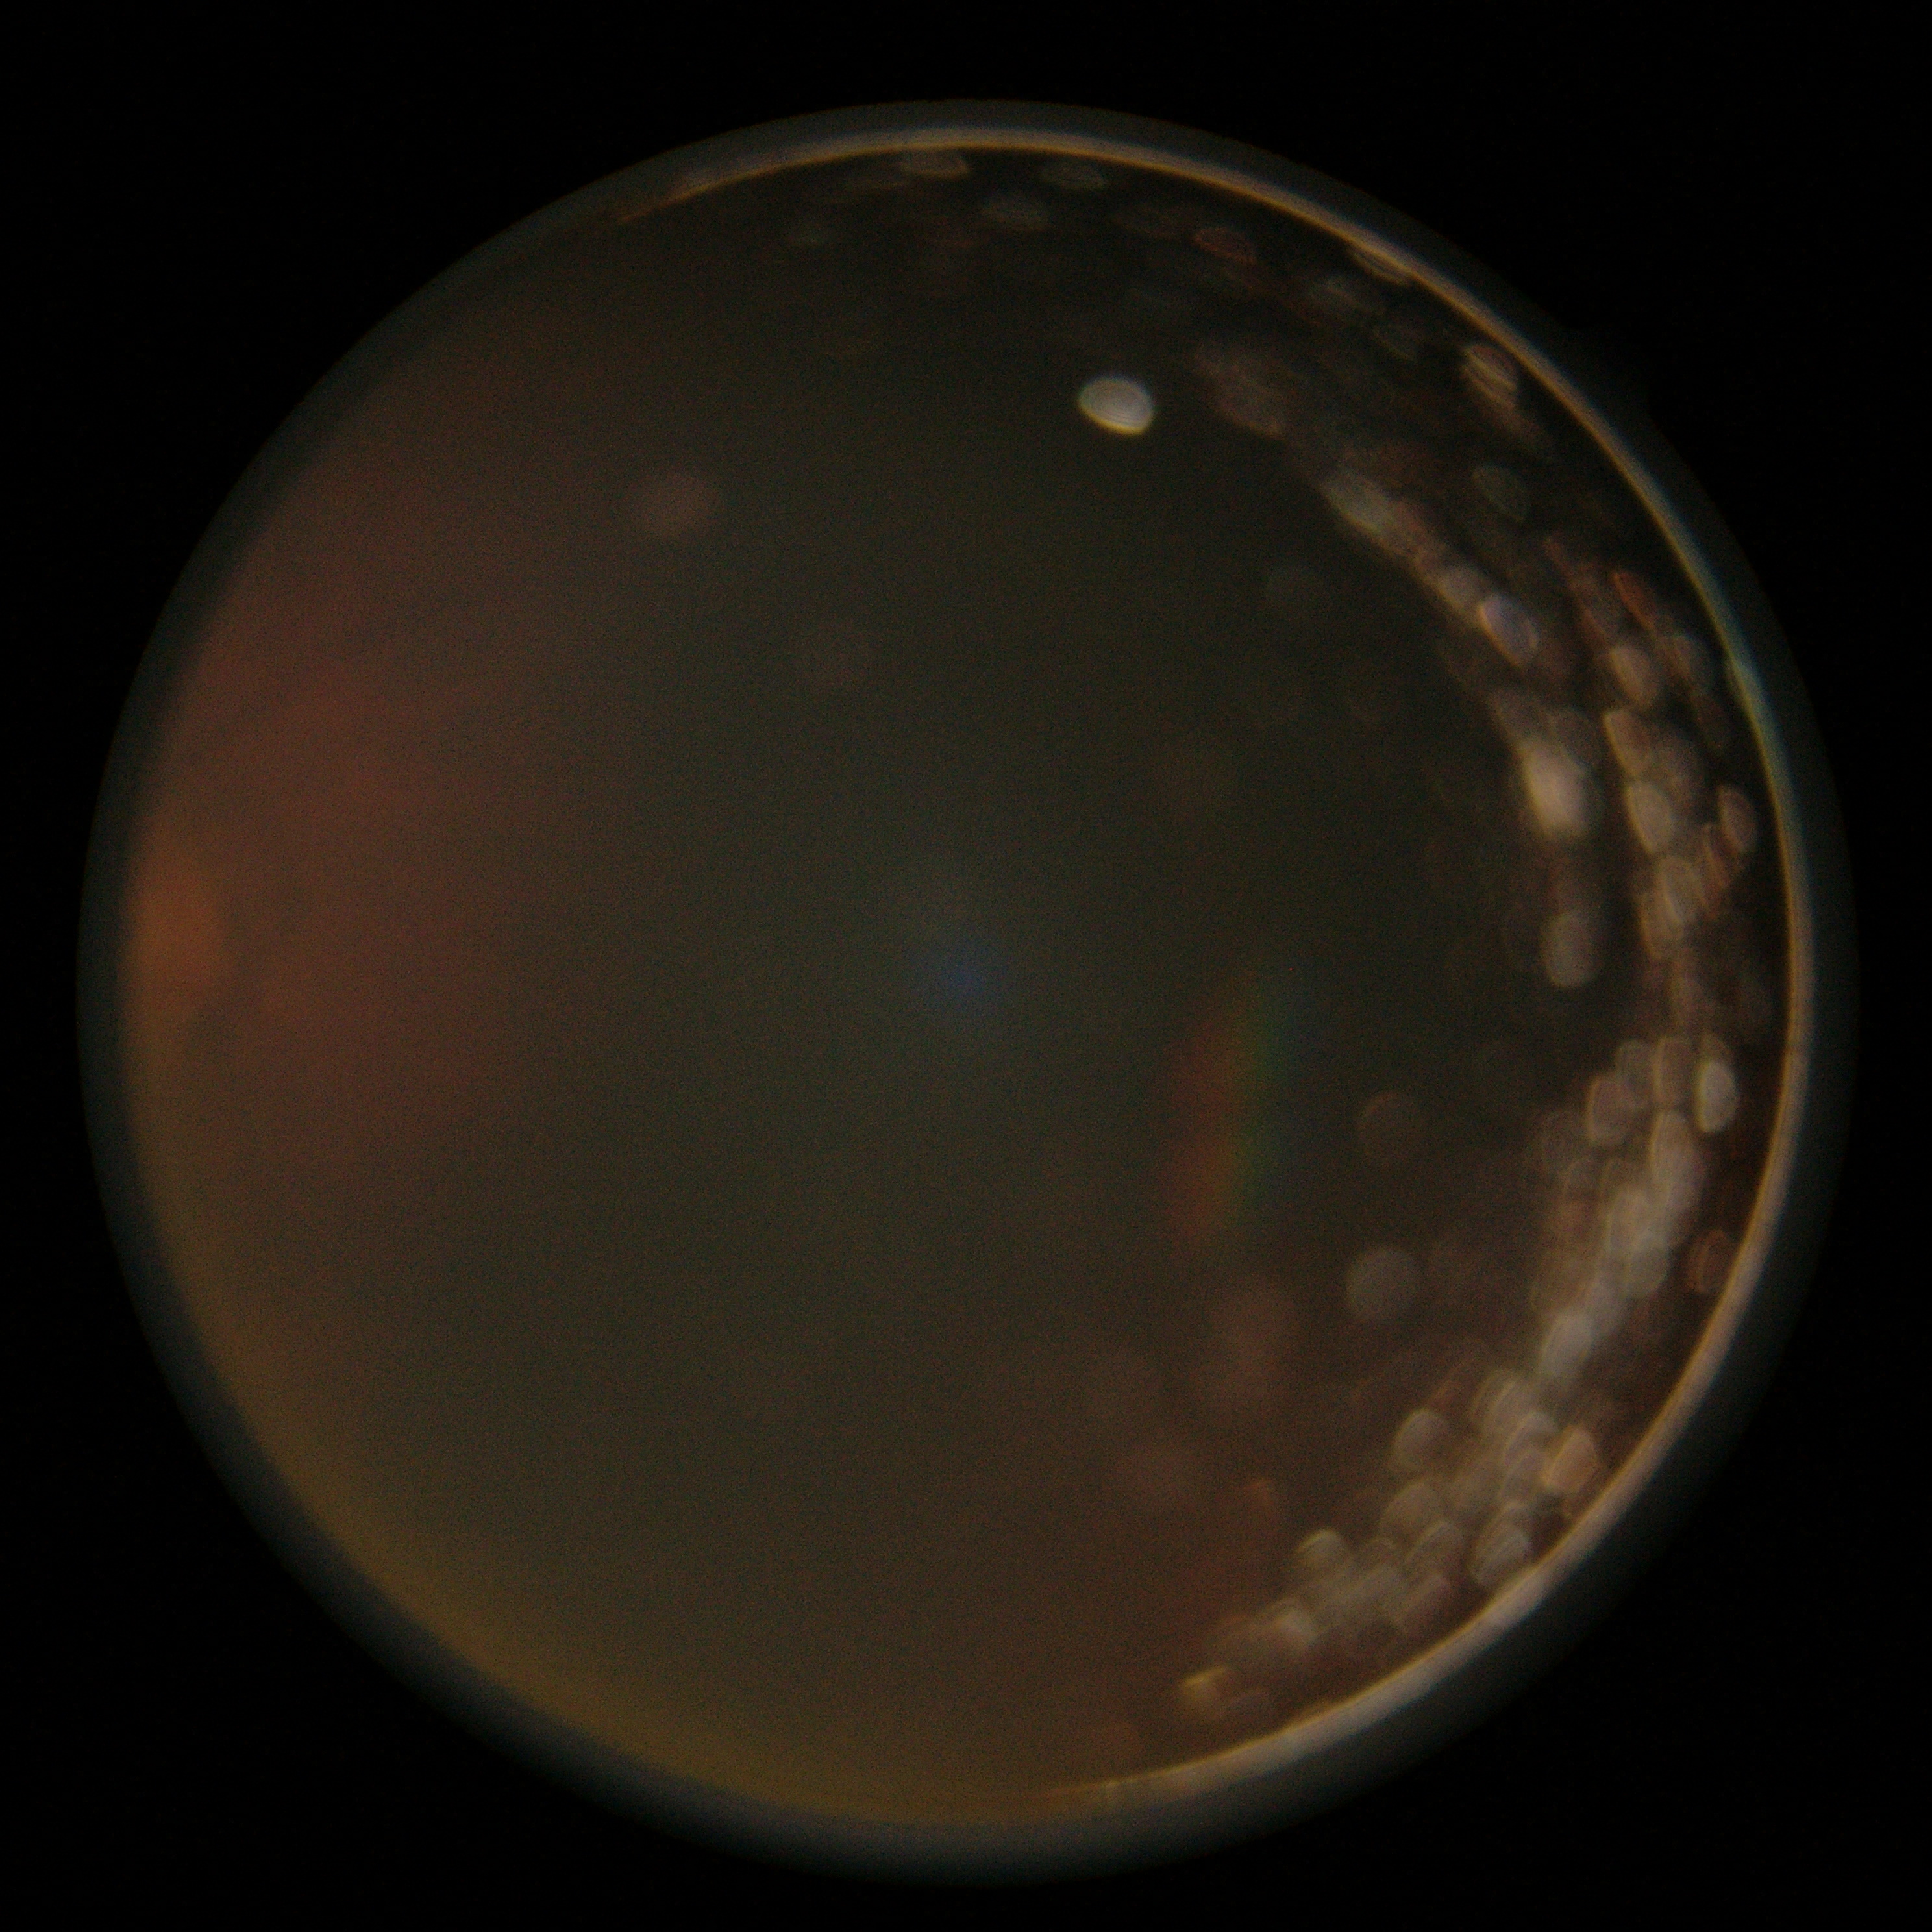
DR: ungradable